Age 68; IOP 16 mmHg; captured on a Topcon TRC-NW400 fundus camera
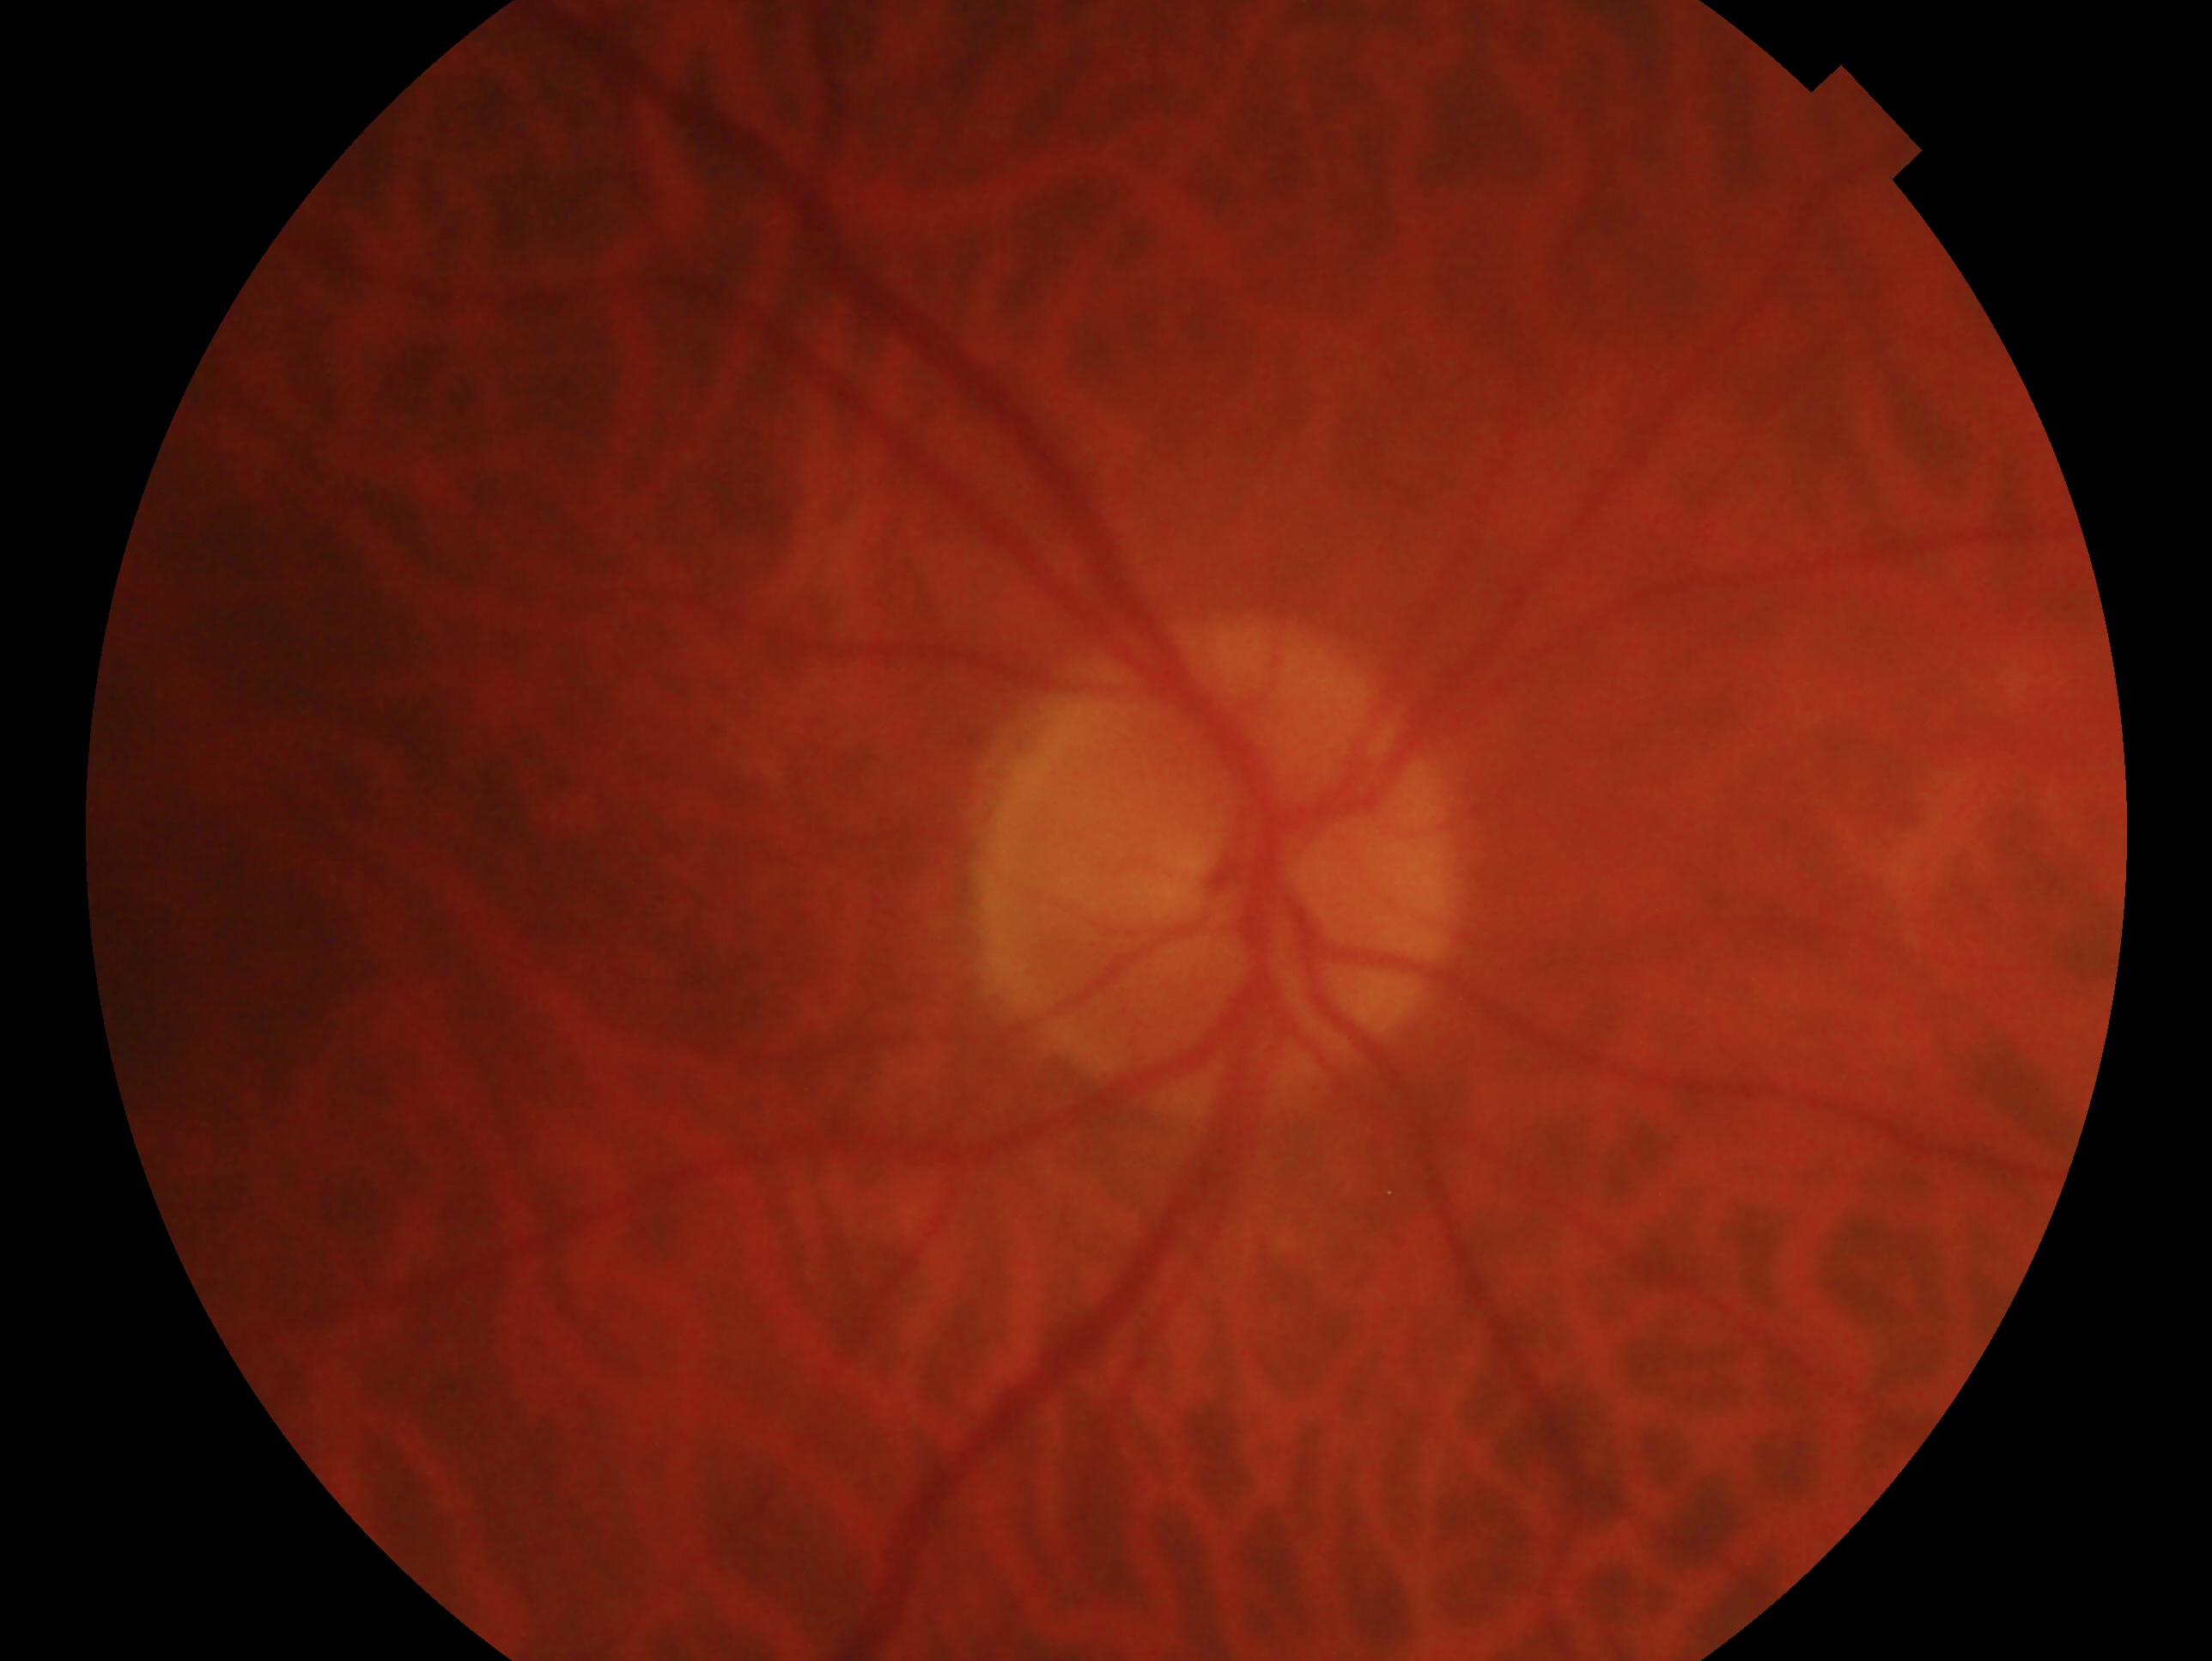 Assessment: no signs of glaucoma. This is the right eye.